Infant wide-field fundus photograph:
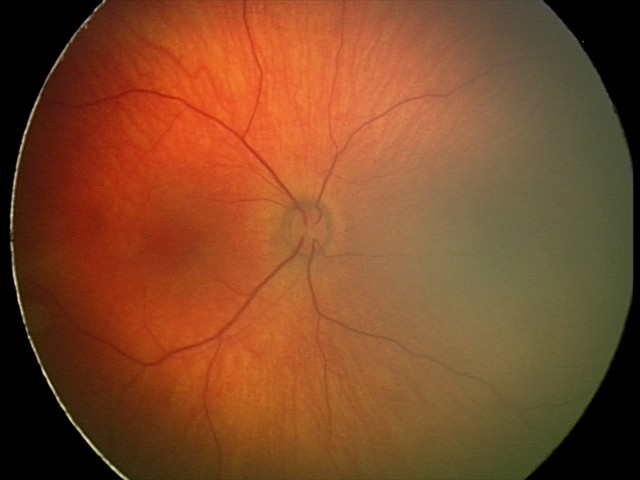 Screening series with retinal hemorrhages.